2228 by 1652 pixels. Central posterior field — 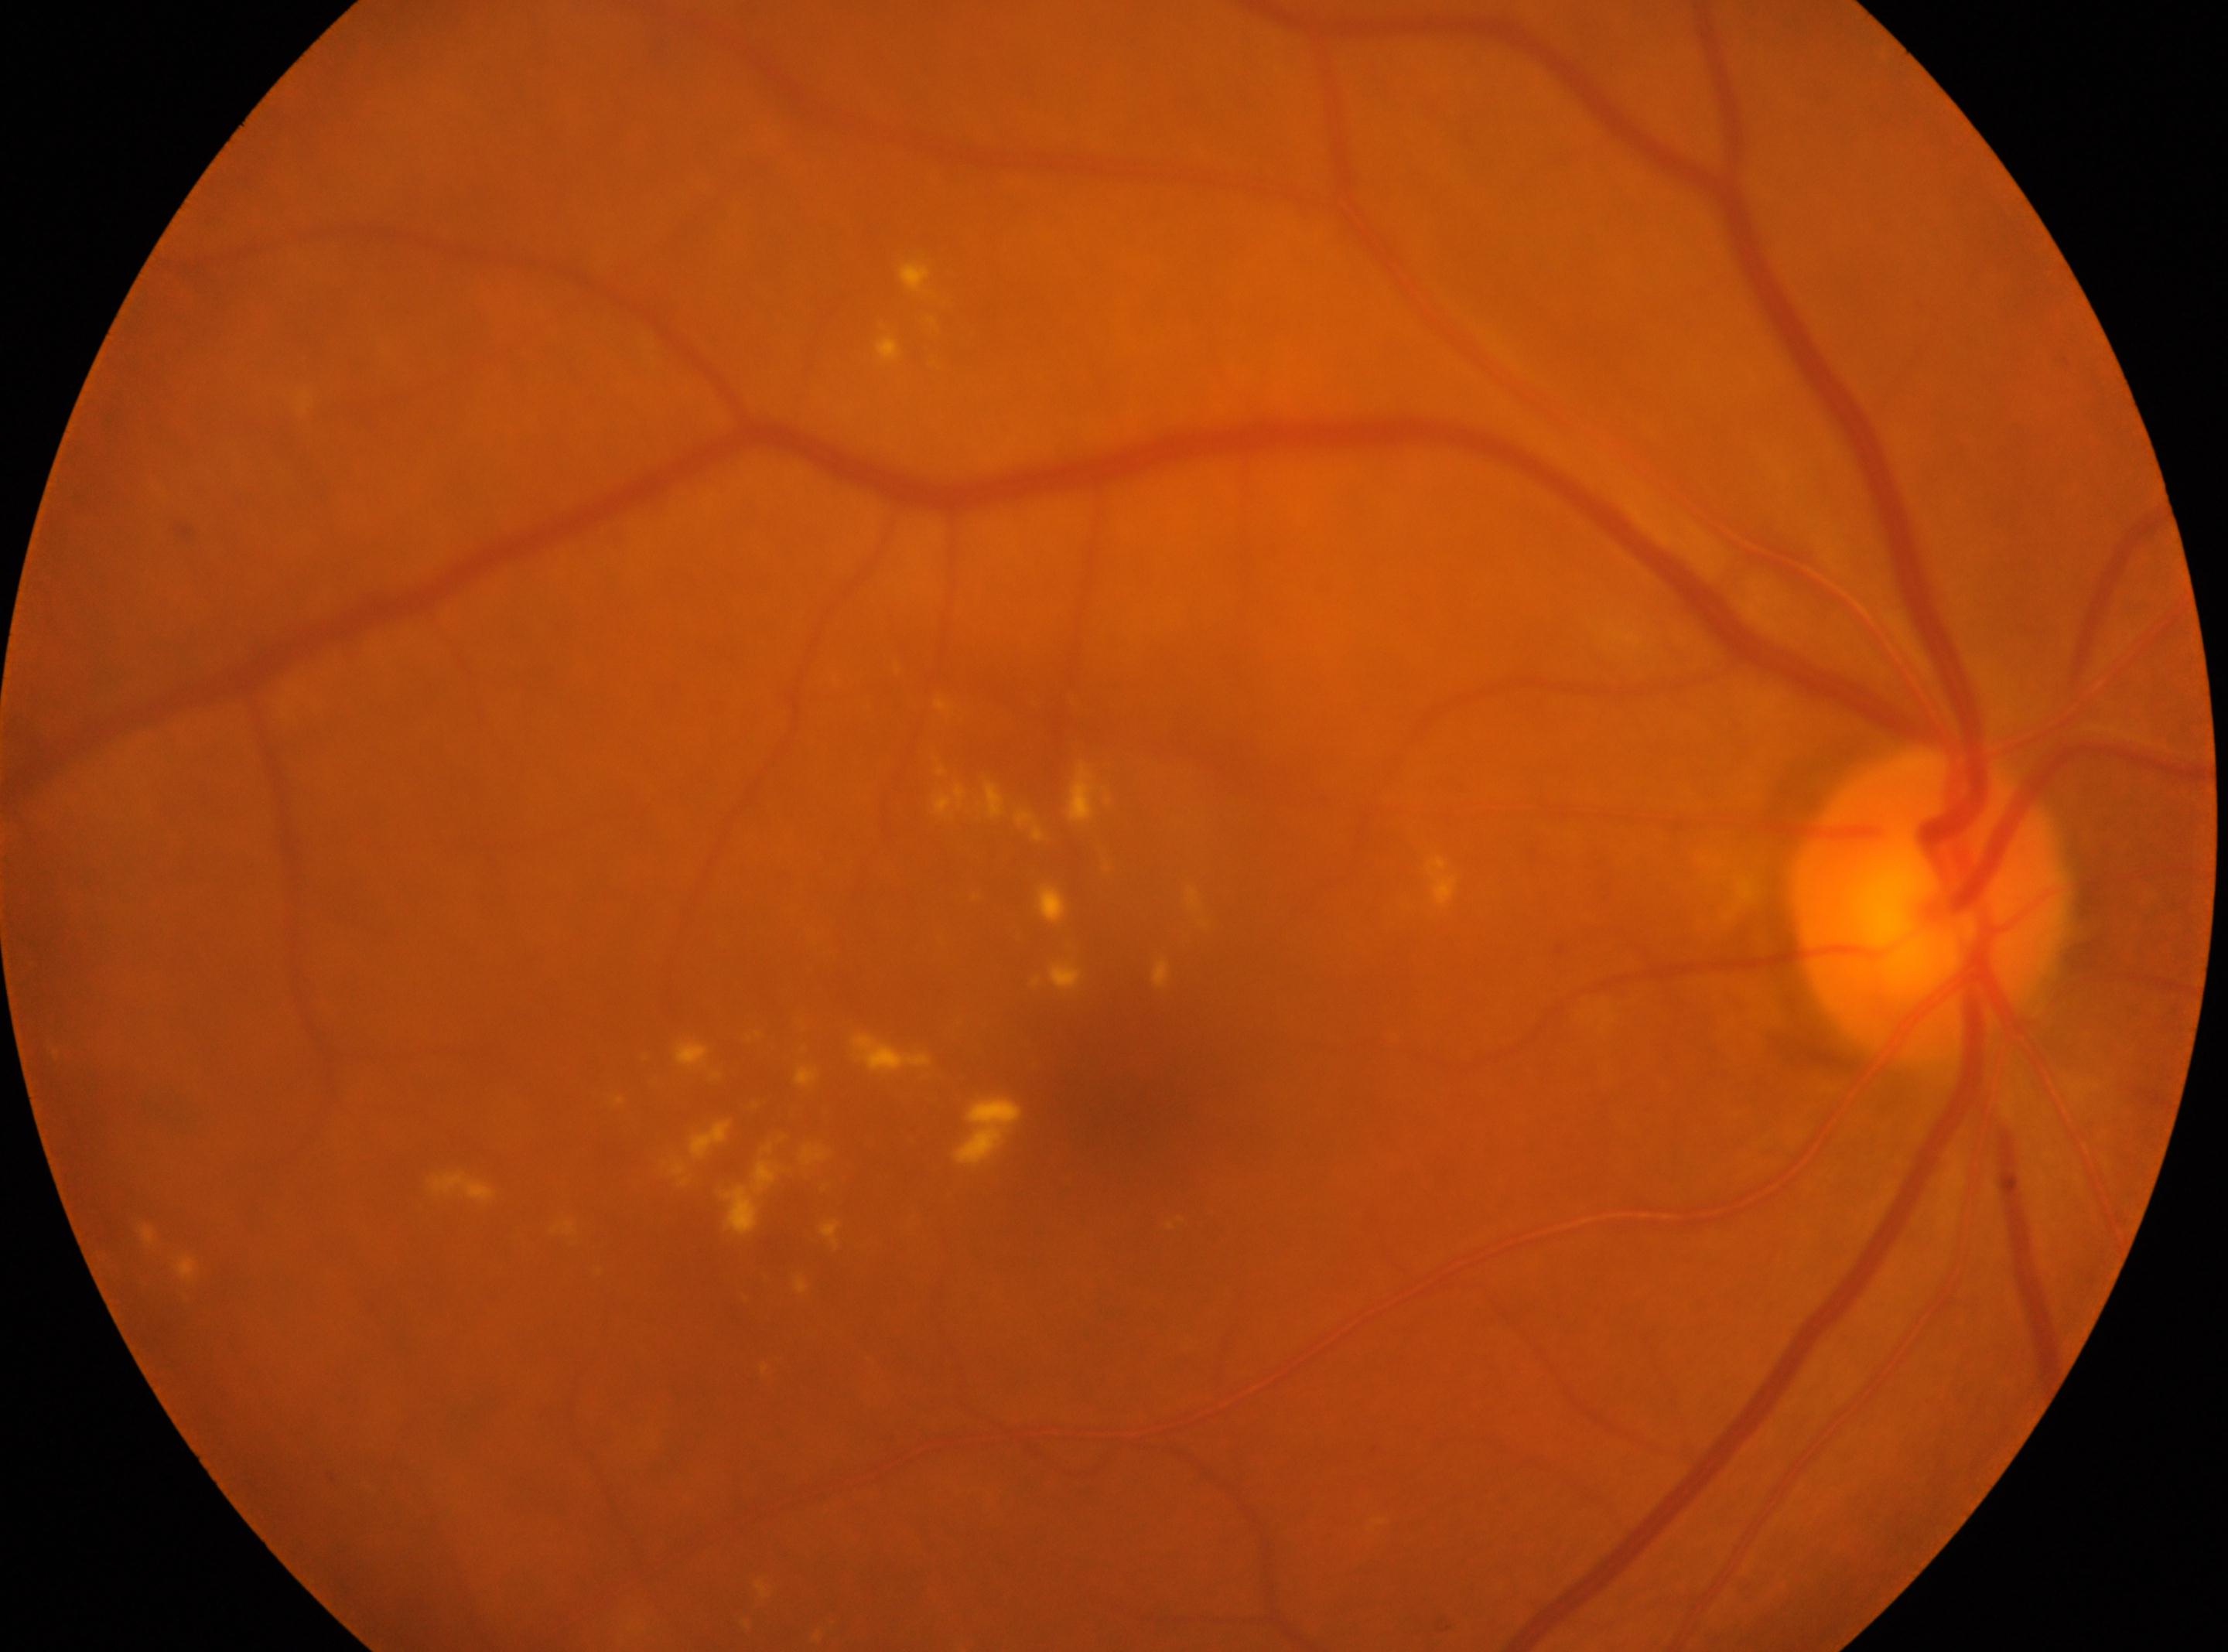

ONH: (x: 1931, y: 906).
DR: 2 — more than just microaneurysms but less than severe NPDR.
Fovea centralis located at (x: 1114, y: 1106).
This is the oculus dexter.